Nidek AFC-330 — 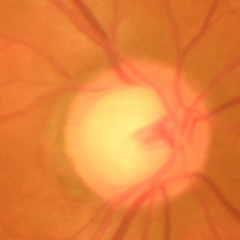
Q: Is glaucoma present?
A: Early glaucomatous changes.